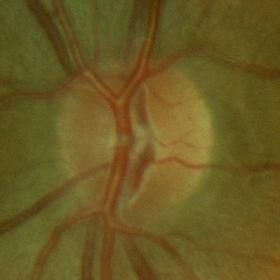
Q: What is the glaucoma diagnosis?
A: No — no glaucomatous findings.